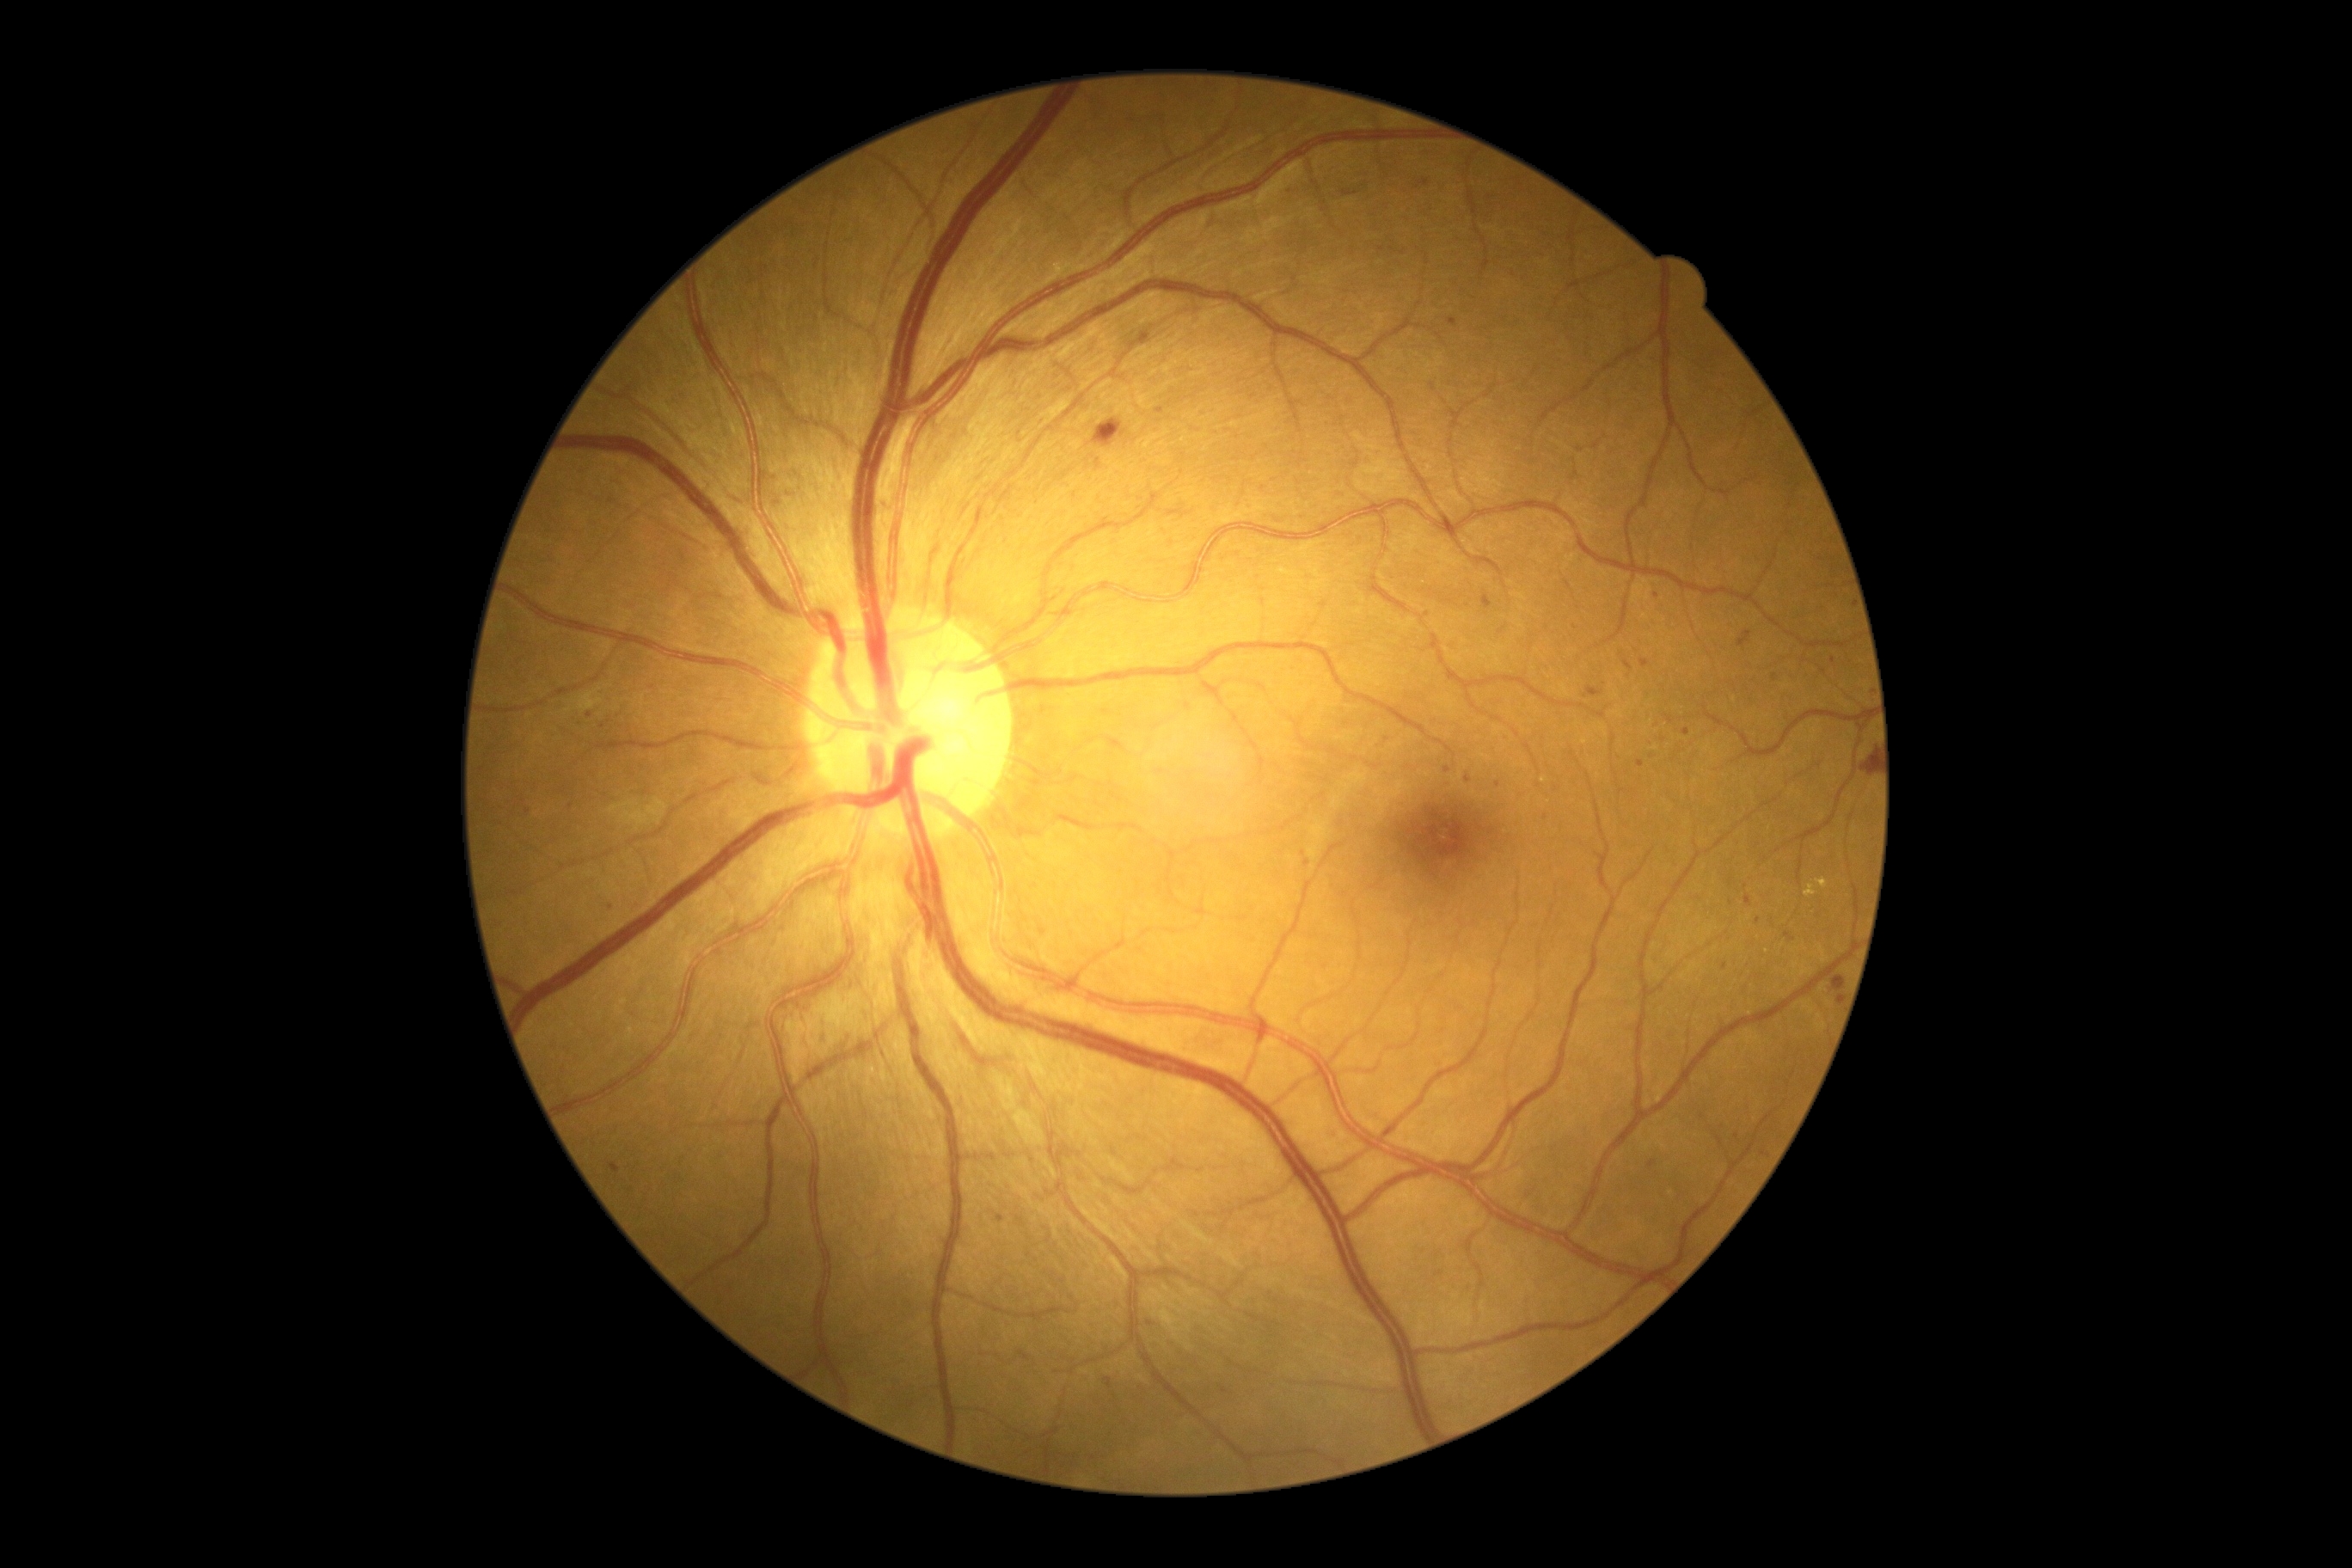 Diabetic retinopathy (DR): 2/4; non-proliferative diabetic retinopathy
Lesions identified (partial list):
hemorrhages (HEs): [left=1093, top=419, right=1127, bottom=448]; [left=1865, top=752, right=1877, bottom=776]; [left=609, top=1163, right=622, bottom=1173]; [left=1832, top=976, right=1846, bottom=991]
Small HEs near x=1839 y=999
hard exudates (EXs): [left=1804, top=886, right=1816, bottom=898]; [left=1816, top=878, right=1828, bottom=890]
microaneurysms (MAs) (subset): [left=1416, top=180, right=1430, bottom=190]; [left=1737, top=630, right=1753, bottom=649]; [left=1639, top=659, right=1650, bottom=668]; [left=1648, top=1161, right=1658, bottom=1168]; [left=1328, top=1130, right=1337, bottom=1142]; [left=1466, top=775, right=1473, bottom=783]
Small MAs near x=1775 y=678; x=1304 y=853; x=1498 y=785; x=1656 y=596; x=1758 y=920; x=612 y=908; x=528 y=812; x=1448 y=771; x=1731 y=904
soft exudates (SEs) (subset): [left=579, top=690, right=603, bottom=713]; [left=608, top=799, right=668, bottom=831]
Small SEs near x=569 y=711